Pediatric wide-field fundus photograph.
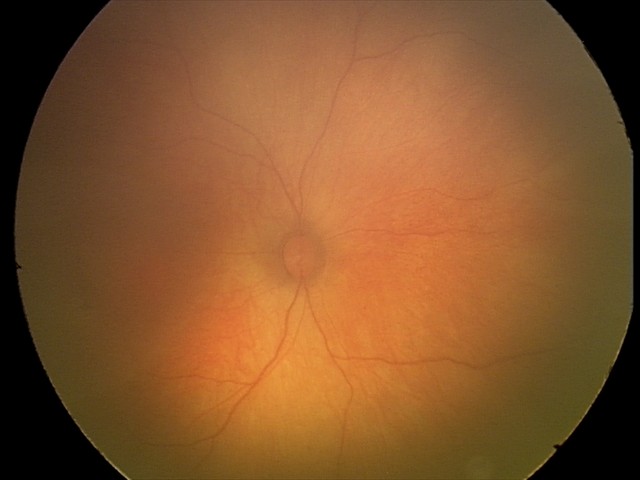
Impression: physiological finding.